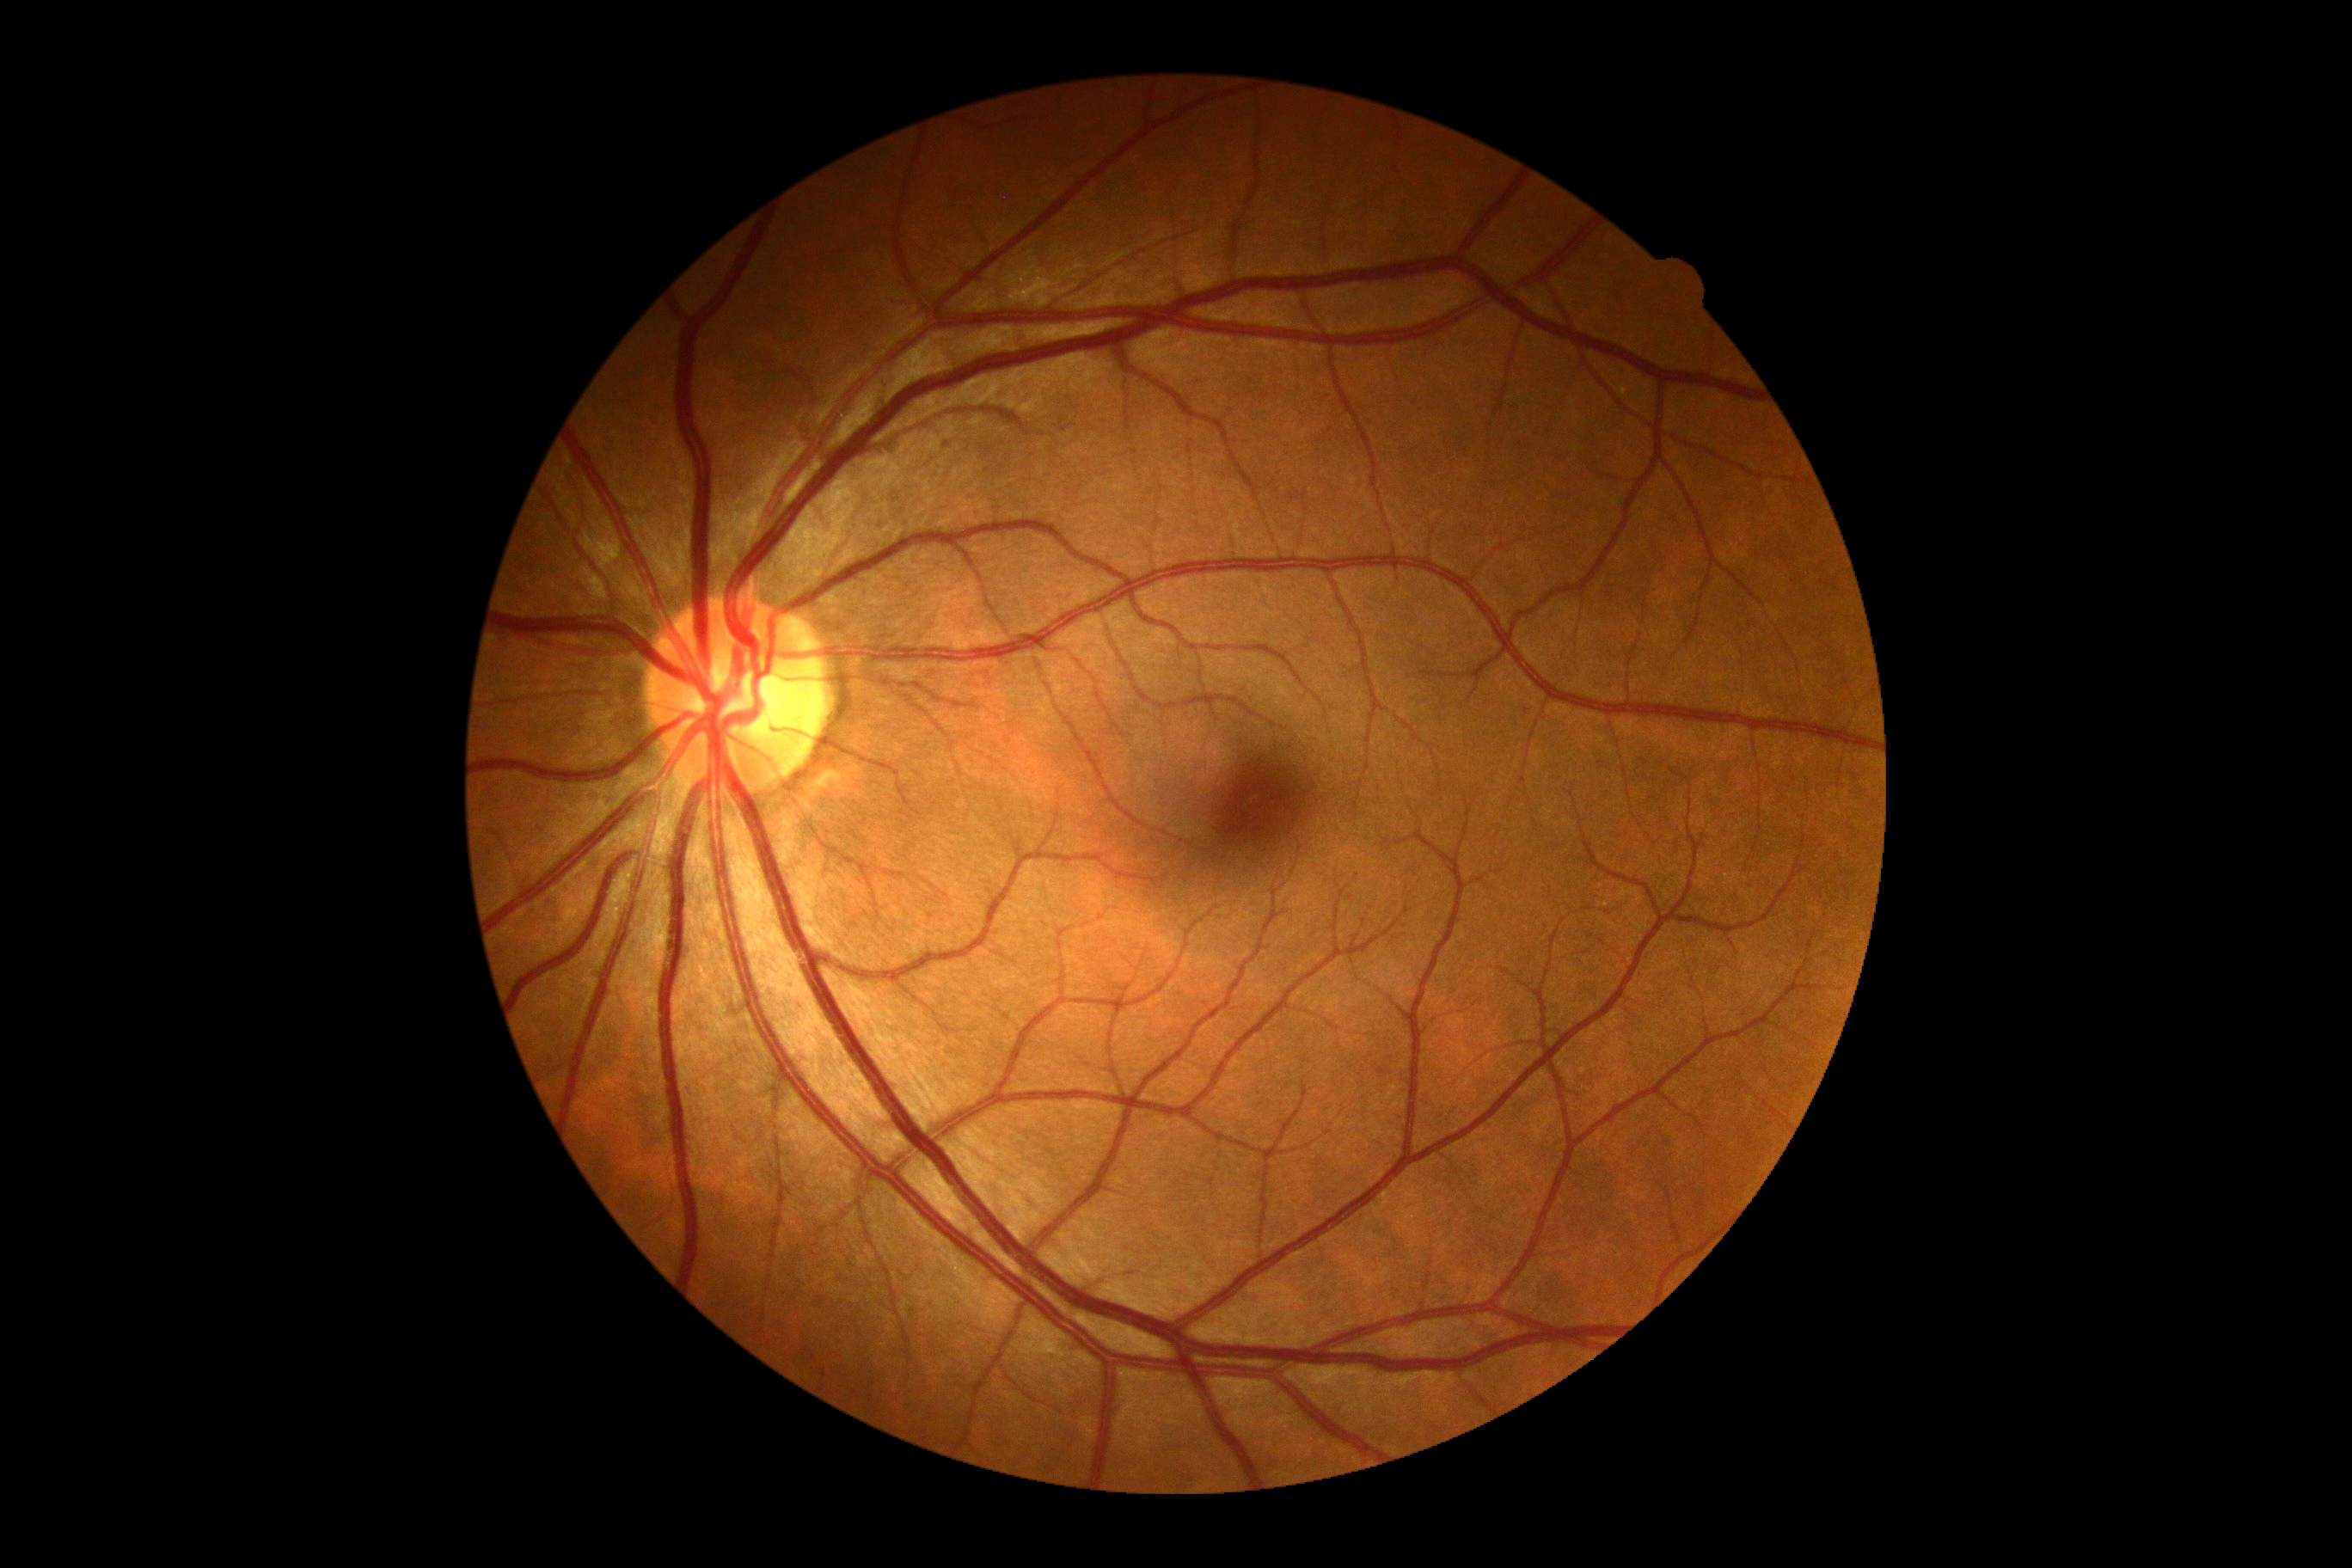

DR: 0/4 | DR impression: no DR findings.